FOV: 45 degrees; CFP; 2352 x 1568 pixels — 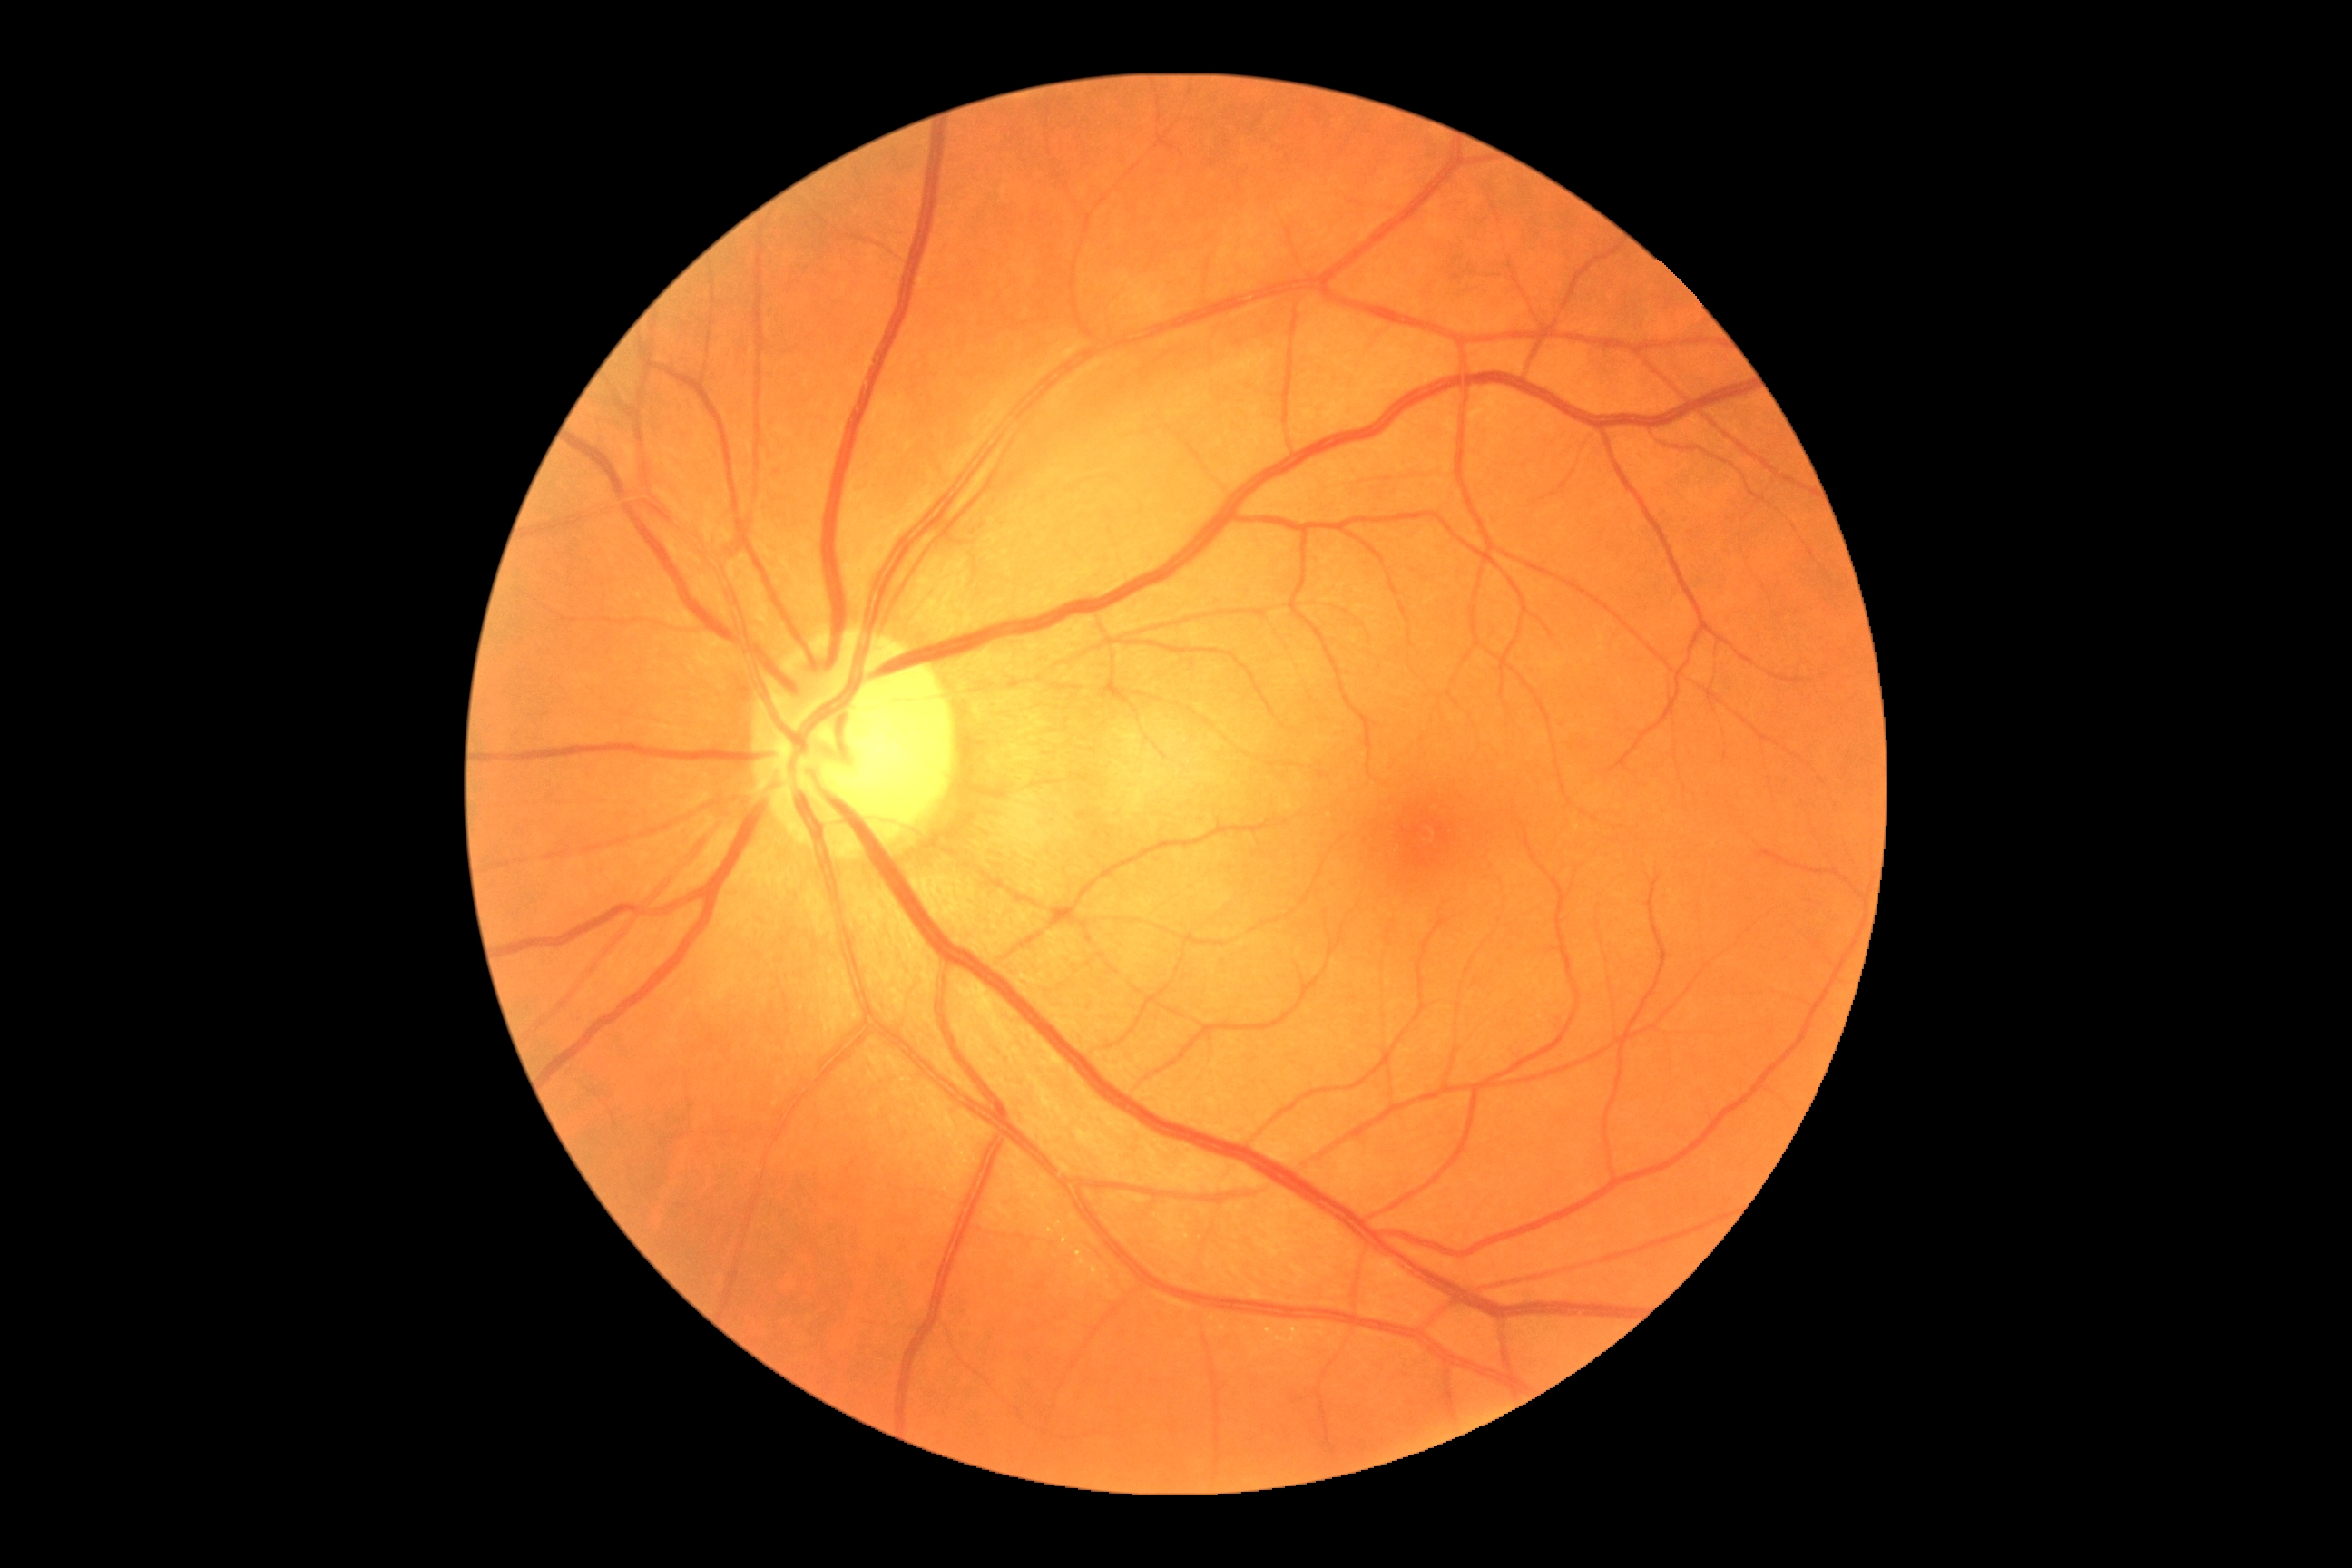
Diabetic retinopathy (DR) is 0. No apparent diabetic retinopathy.